640 x 480 pixels. Wide-field fundus image from infant ROP screening:
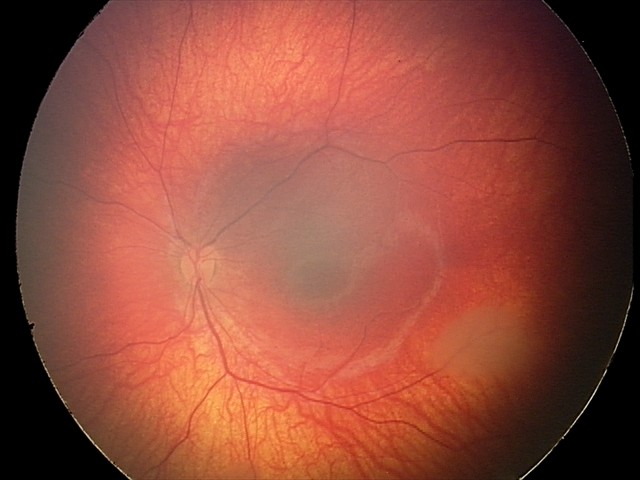
Screening diagnosis: retinal astrocytic hamartoma.